CFP; 45-degree field of view:
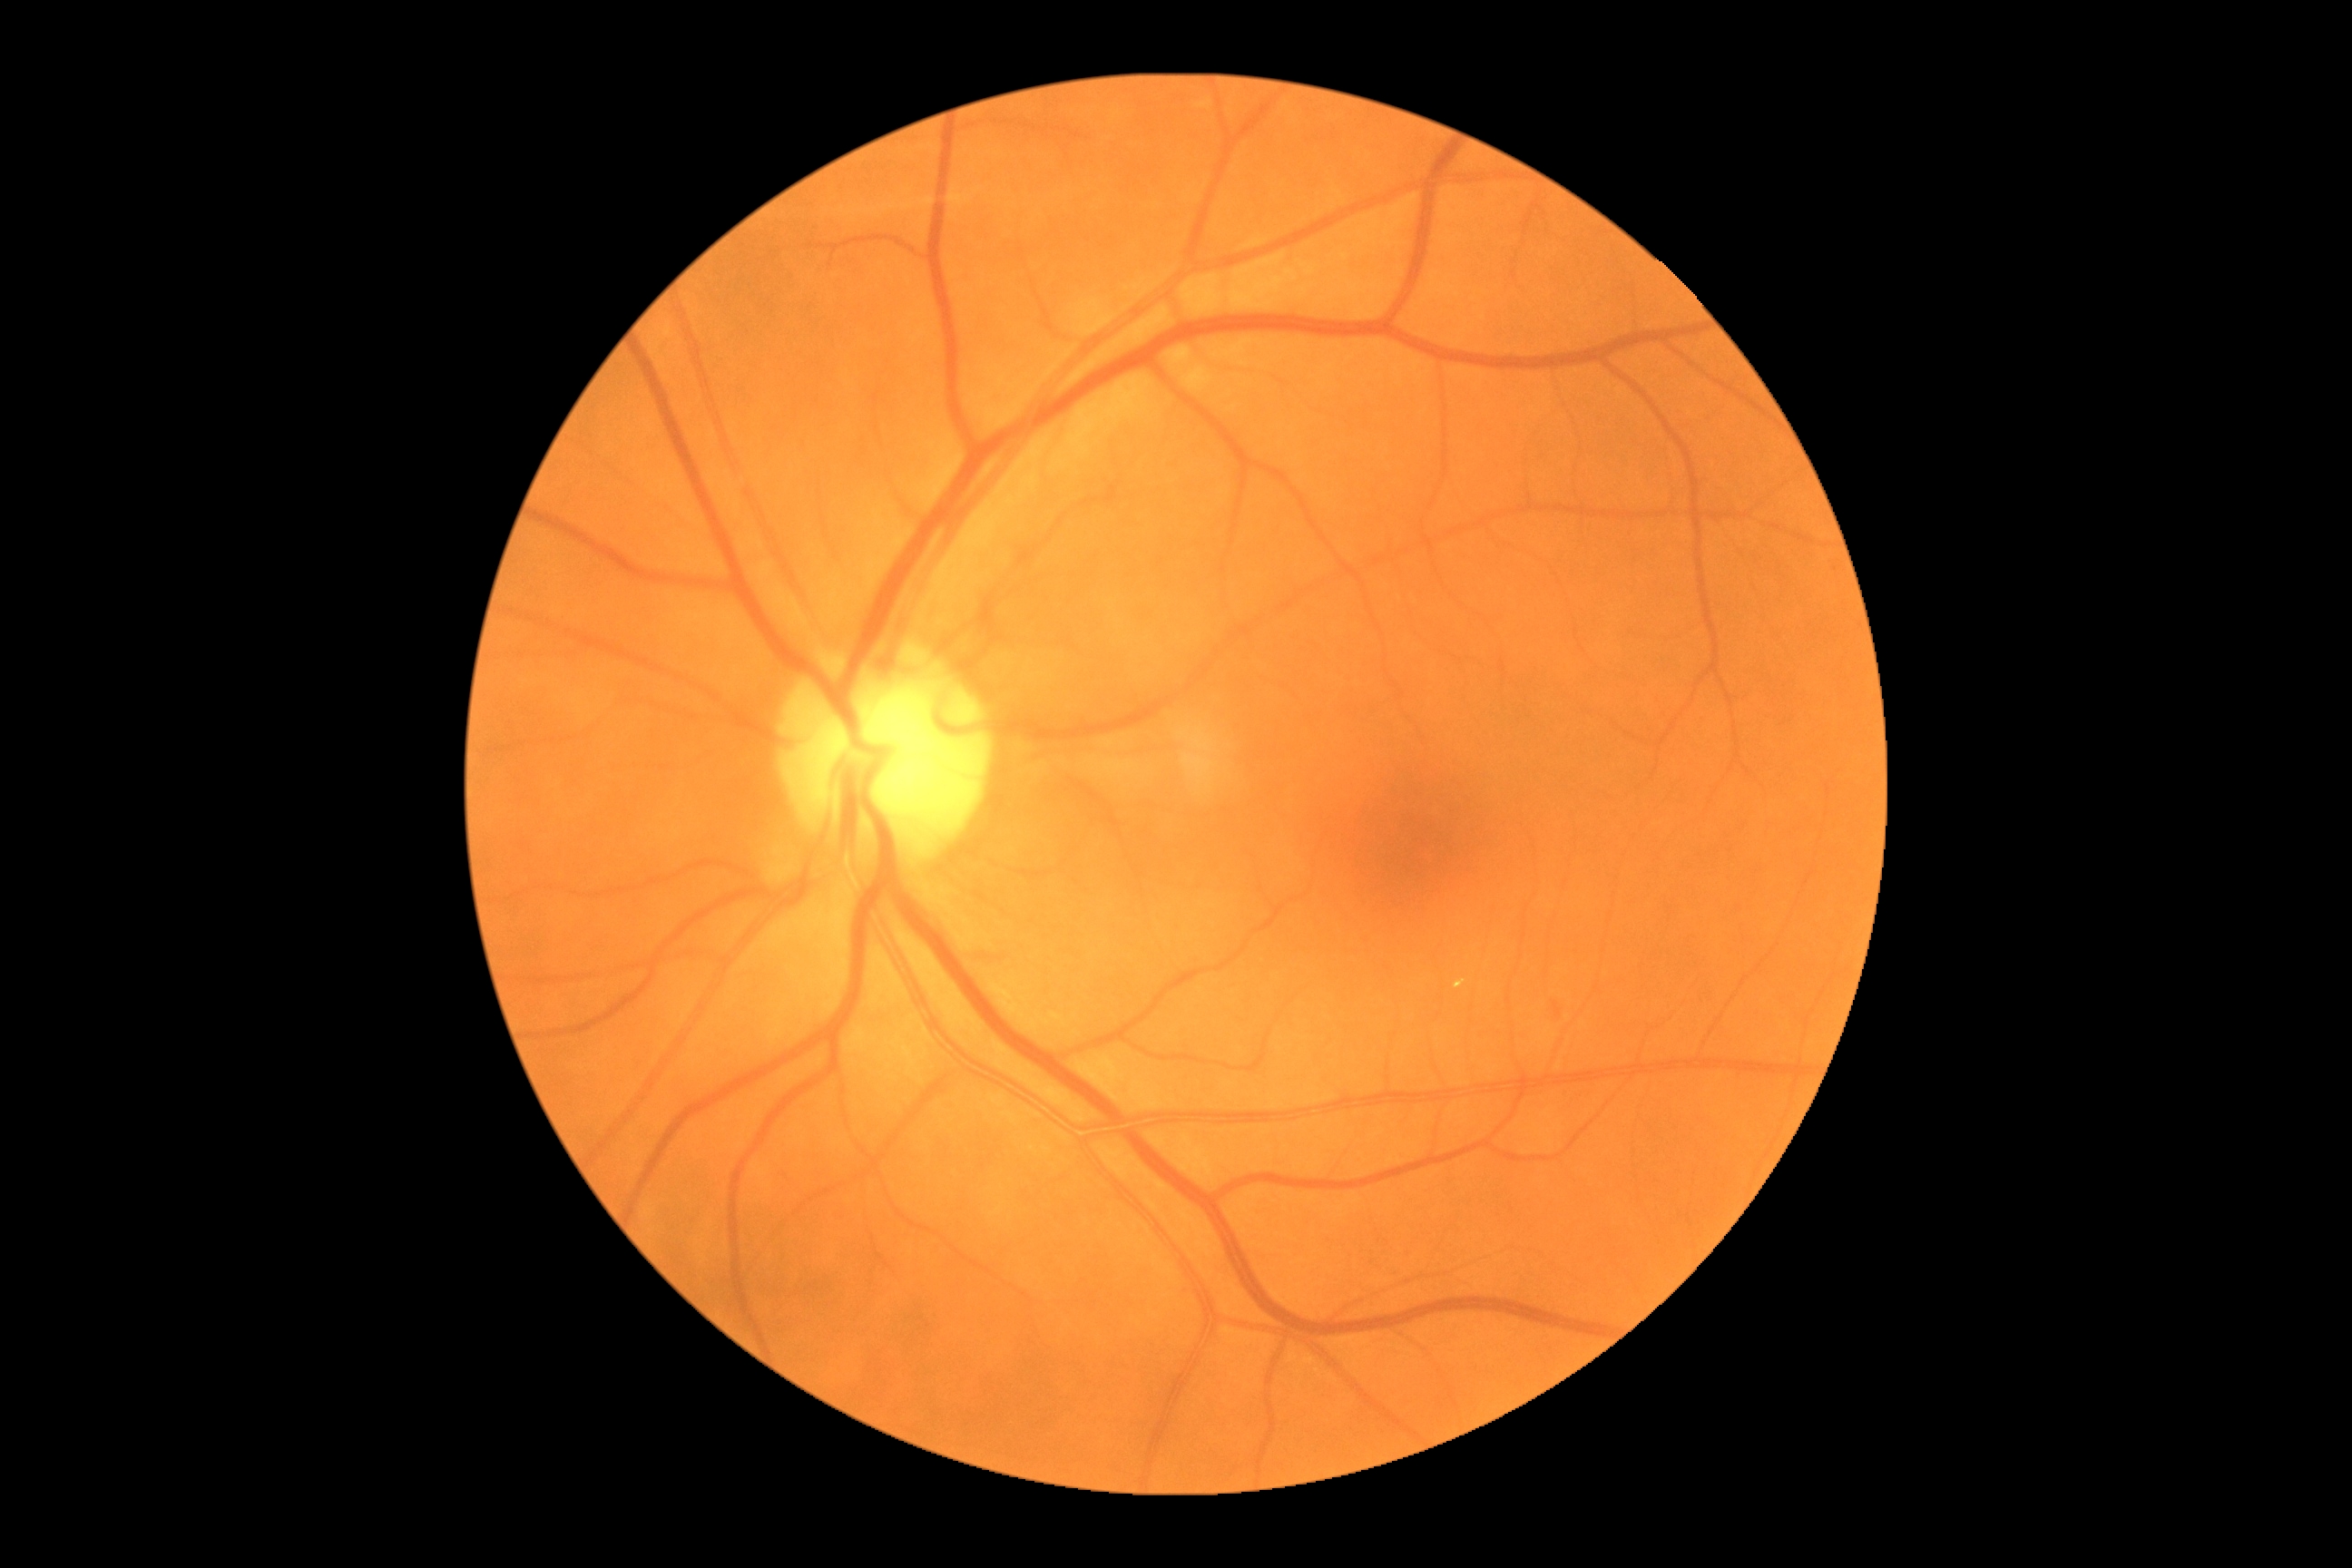 DR grade: 2.
The retinopathy is classified as non-proliferative diabetic retinopathy.